CFP. 2102x1736
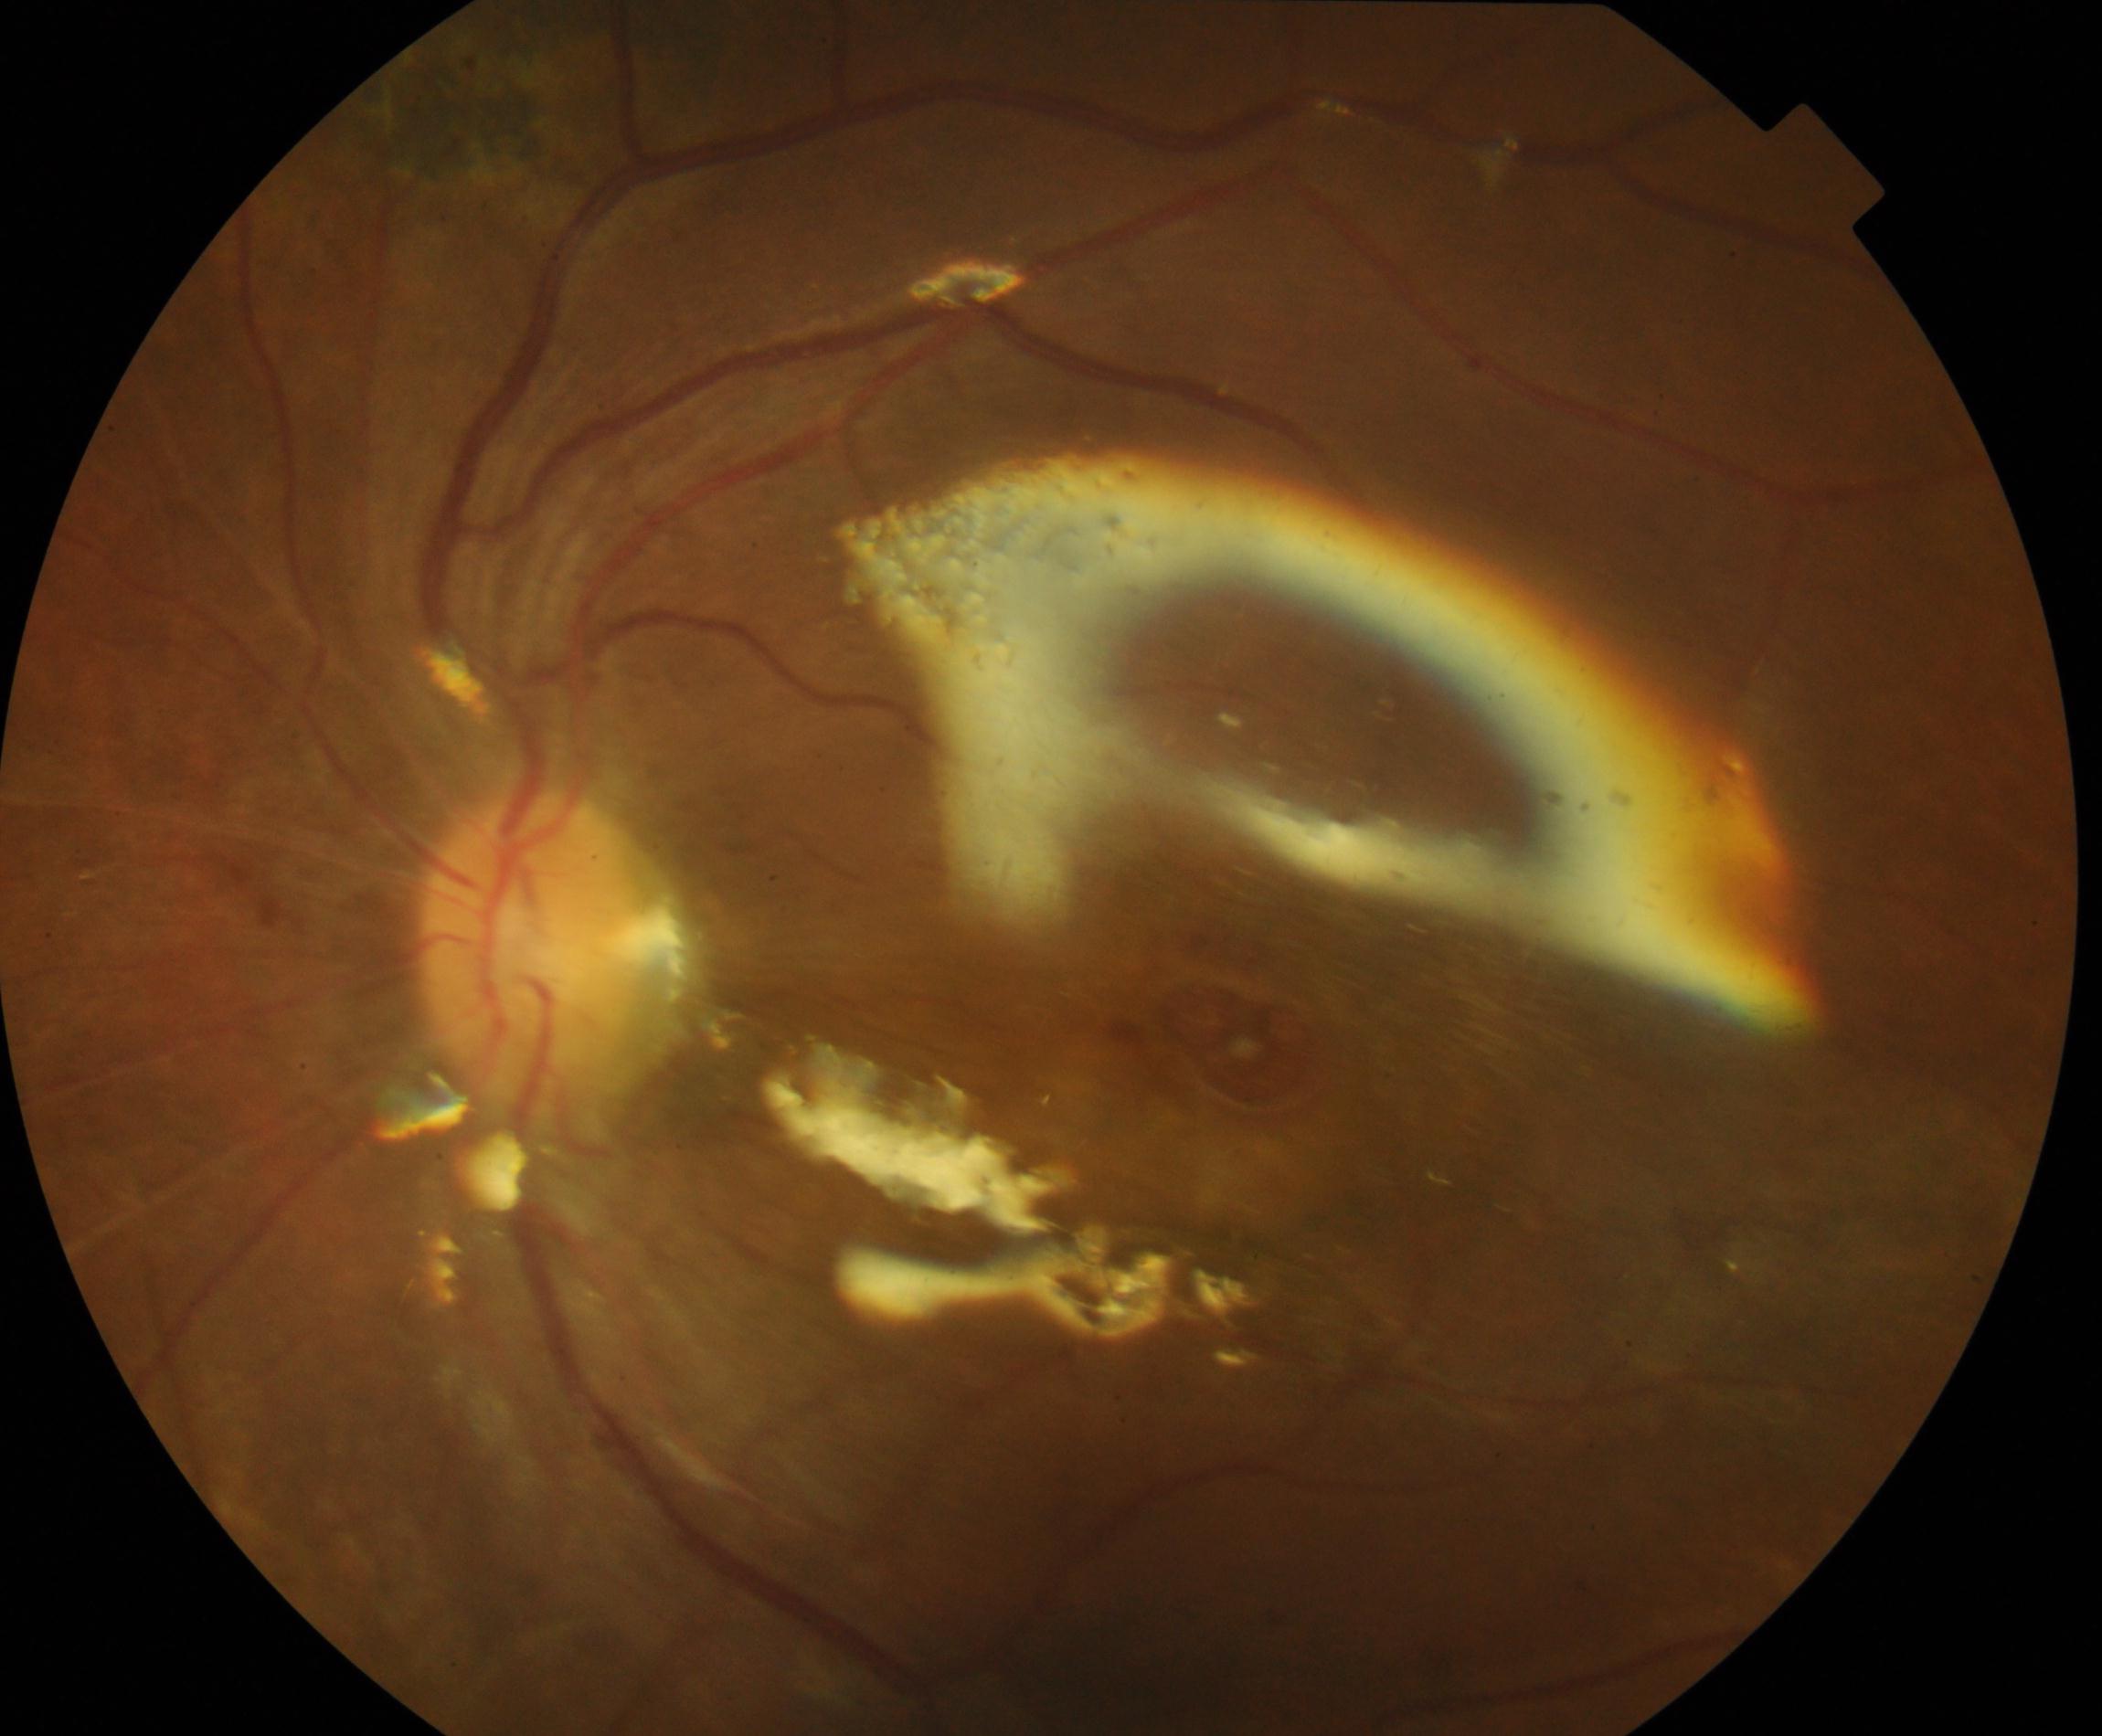 Silicone oil in the eye, consistent with prior treatment.